Acquired on the Clarity RetCam 3 · pediatric wide-field fundus photograph · image size 640x480
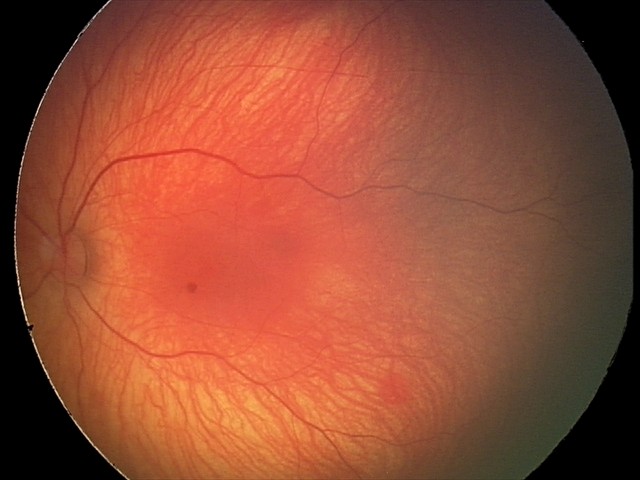
Screening series with retinal hemorrhages.